Tabletop color fundus camera image: 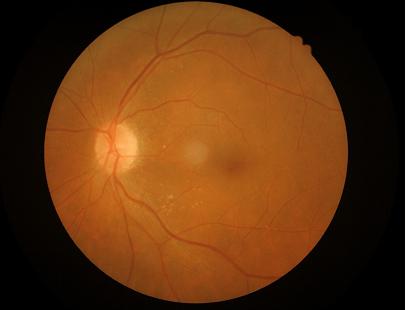 illumination: even
clarity: clear
contrast: adequate
overall_quality: acceptable